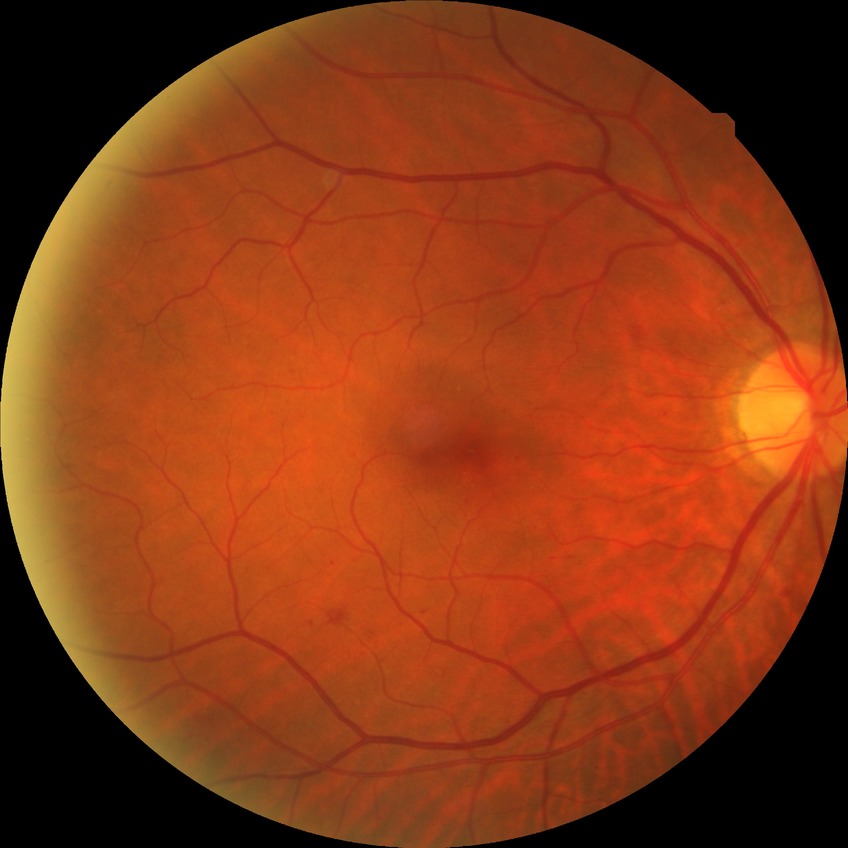

Diabetic retinopathy (DR): pre-proliferative diabetic retinopathy (PPDR).